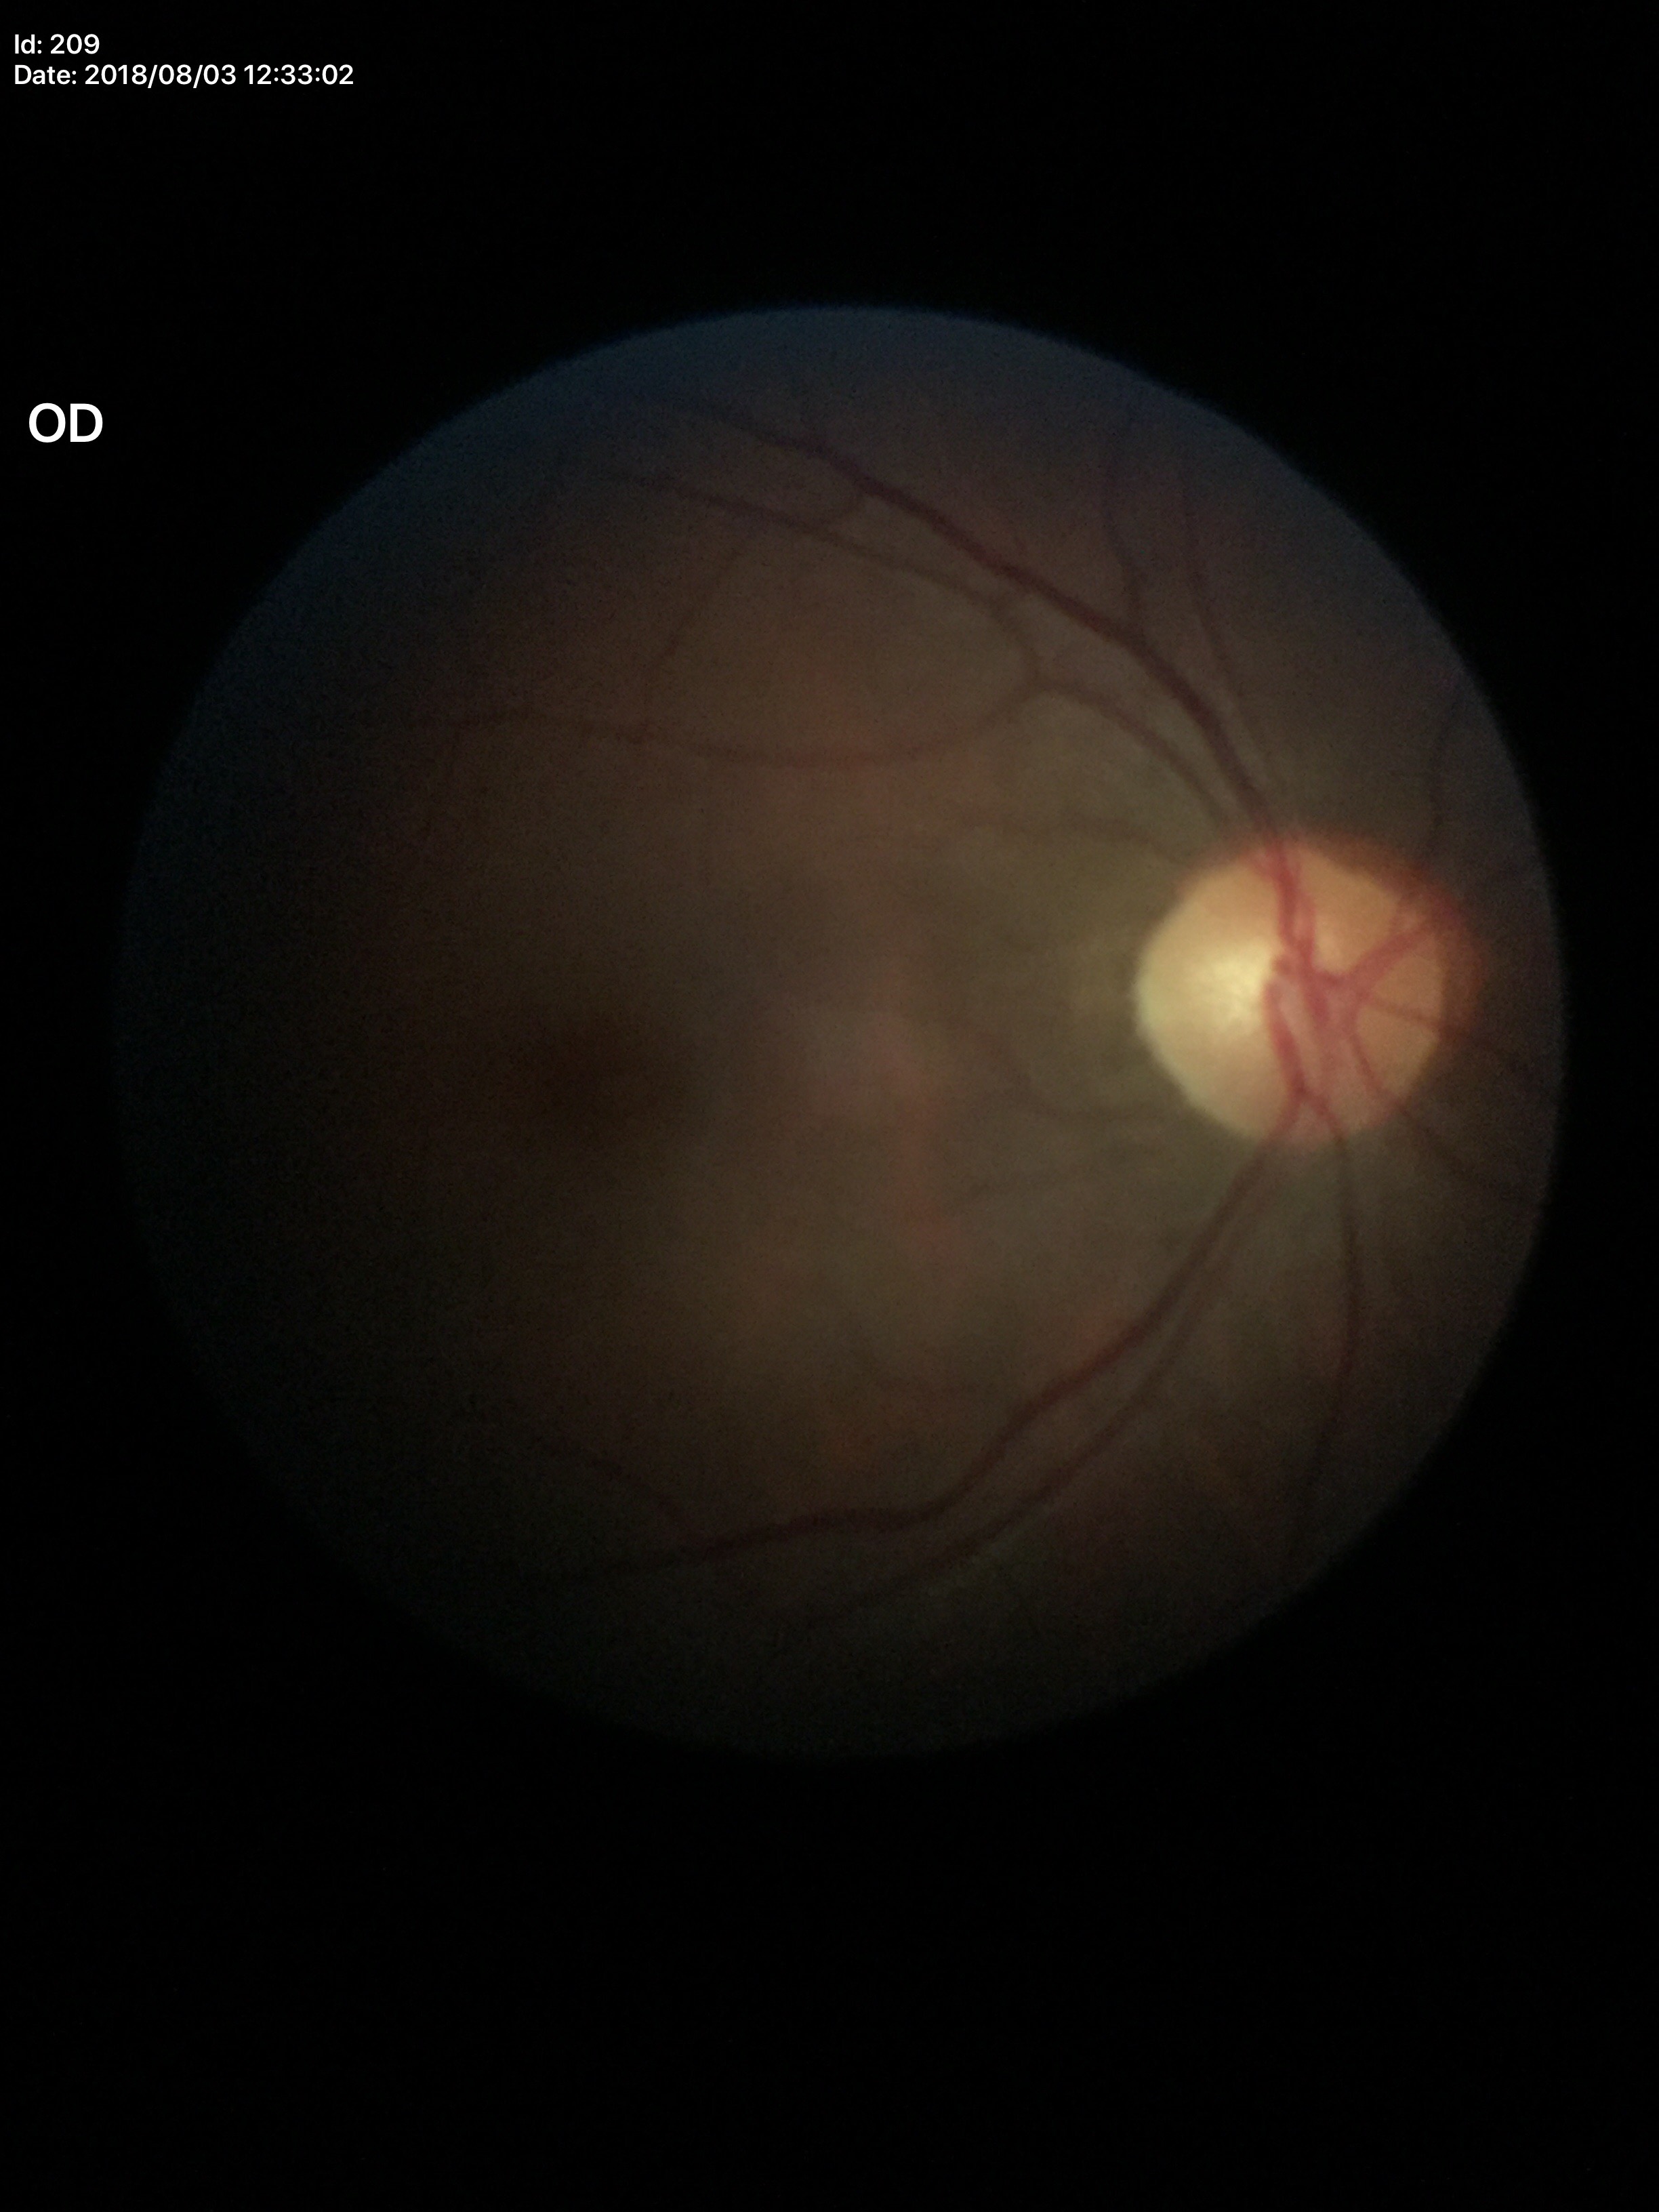
Glaucoma screening = negative, VCDR = 0.49.